Color fundus photograph:
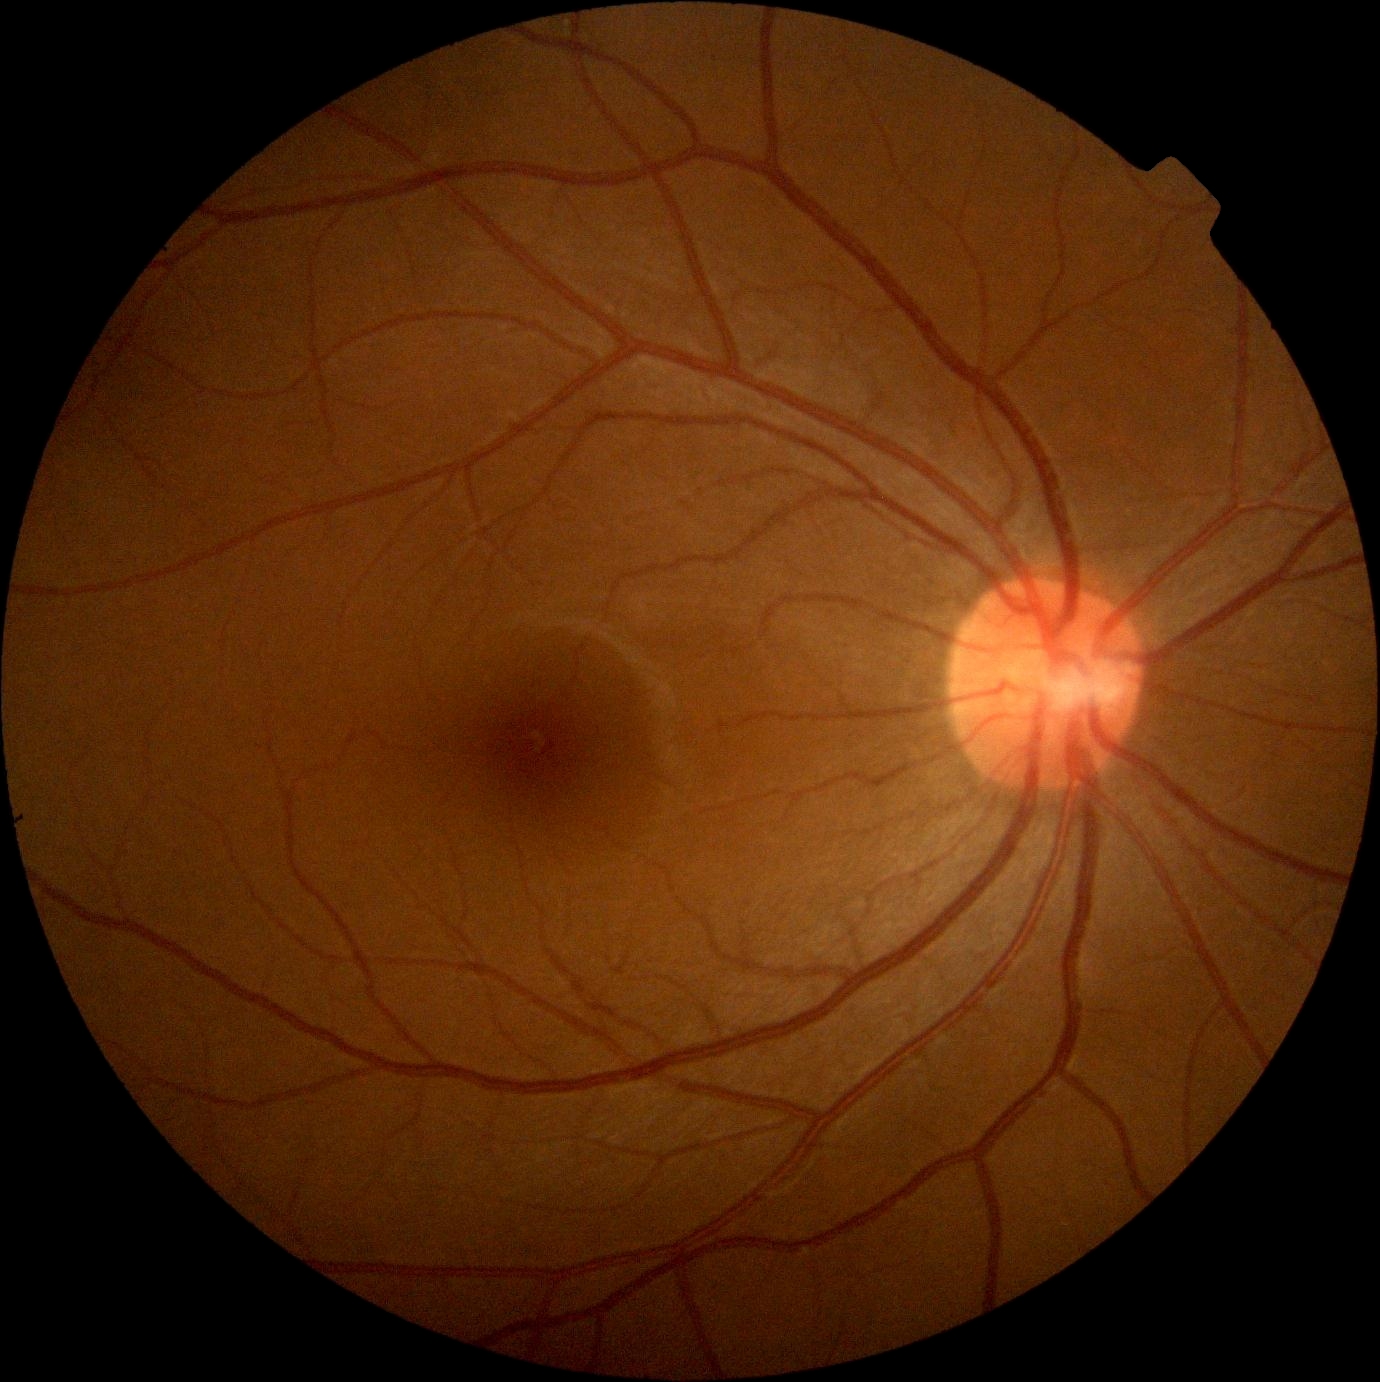
Diabetic retinopathy grade: 0.